Infant wide-field retinal image:
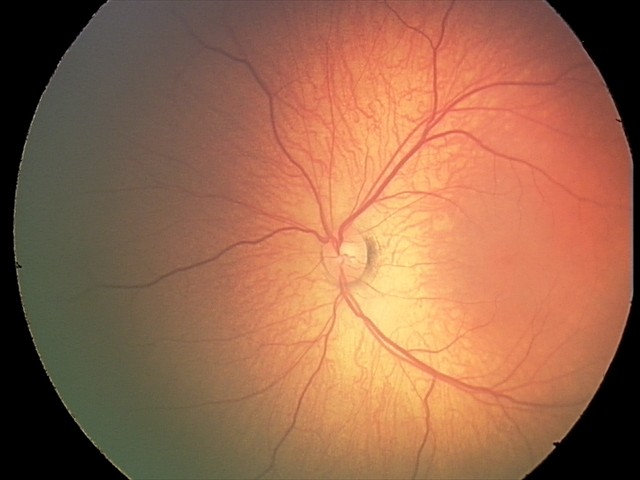 Finding = no abnormalities.